Pediatric retinal photograph (wide-field) · acquired on the Phoenix ICON
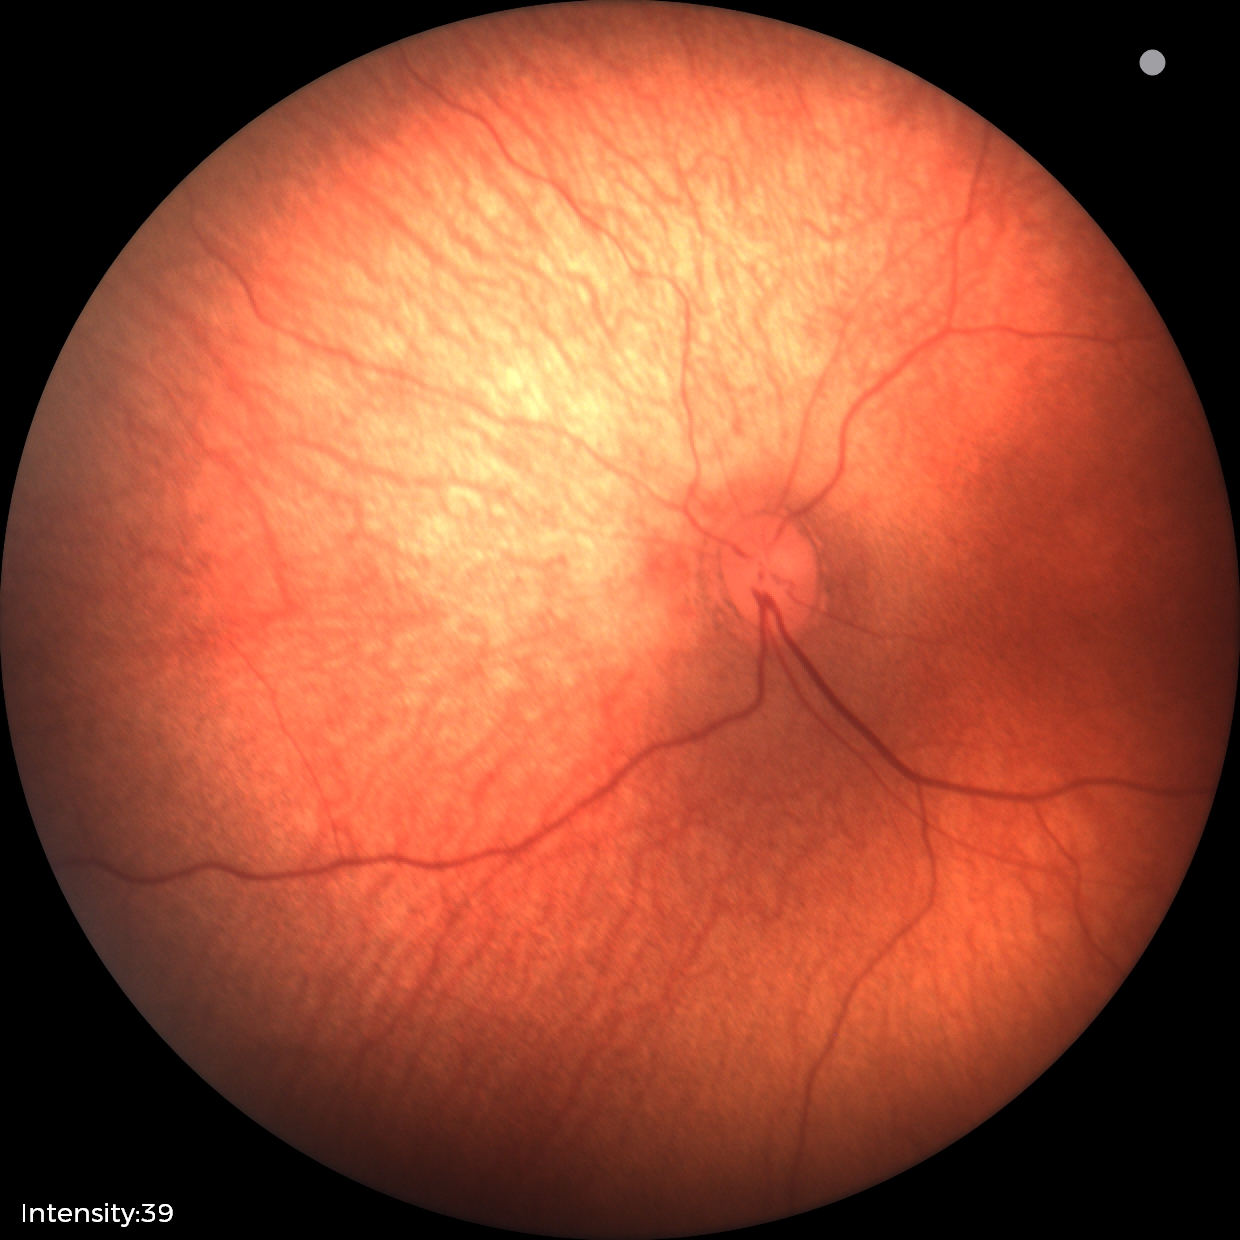
Q: What was the screening finding?
A: no abnormal retinal findings